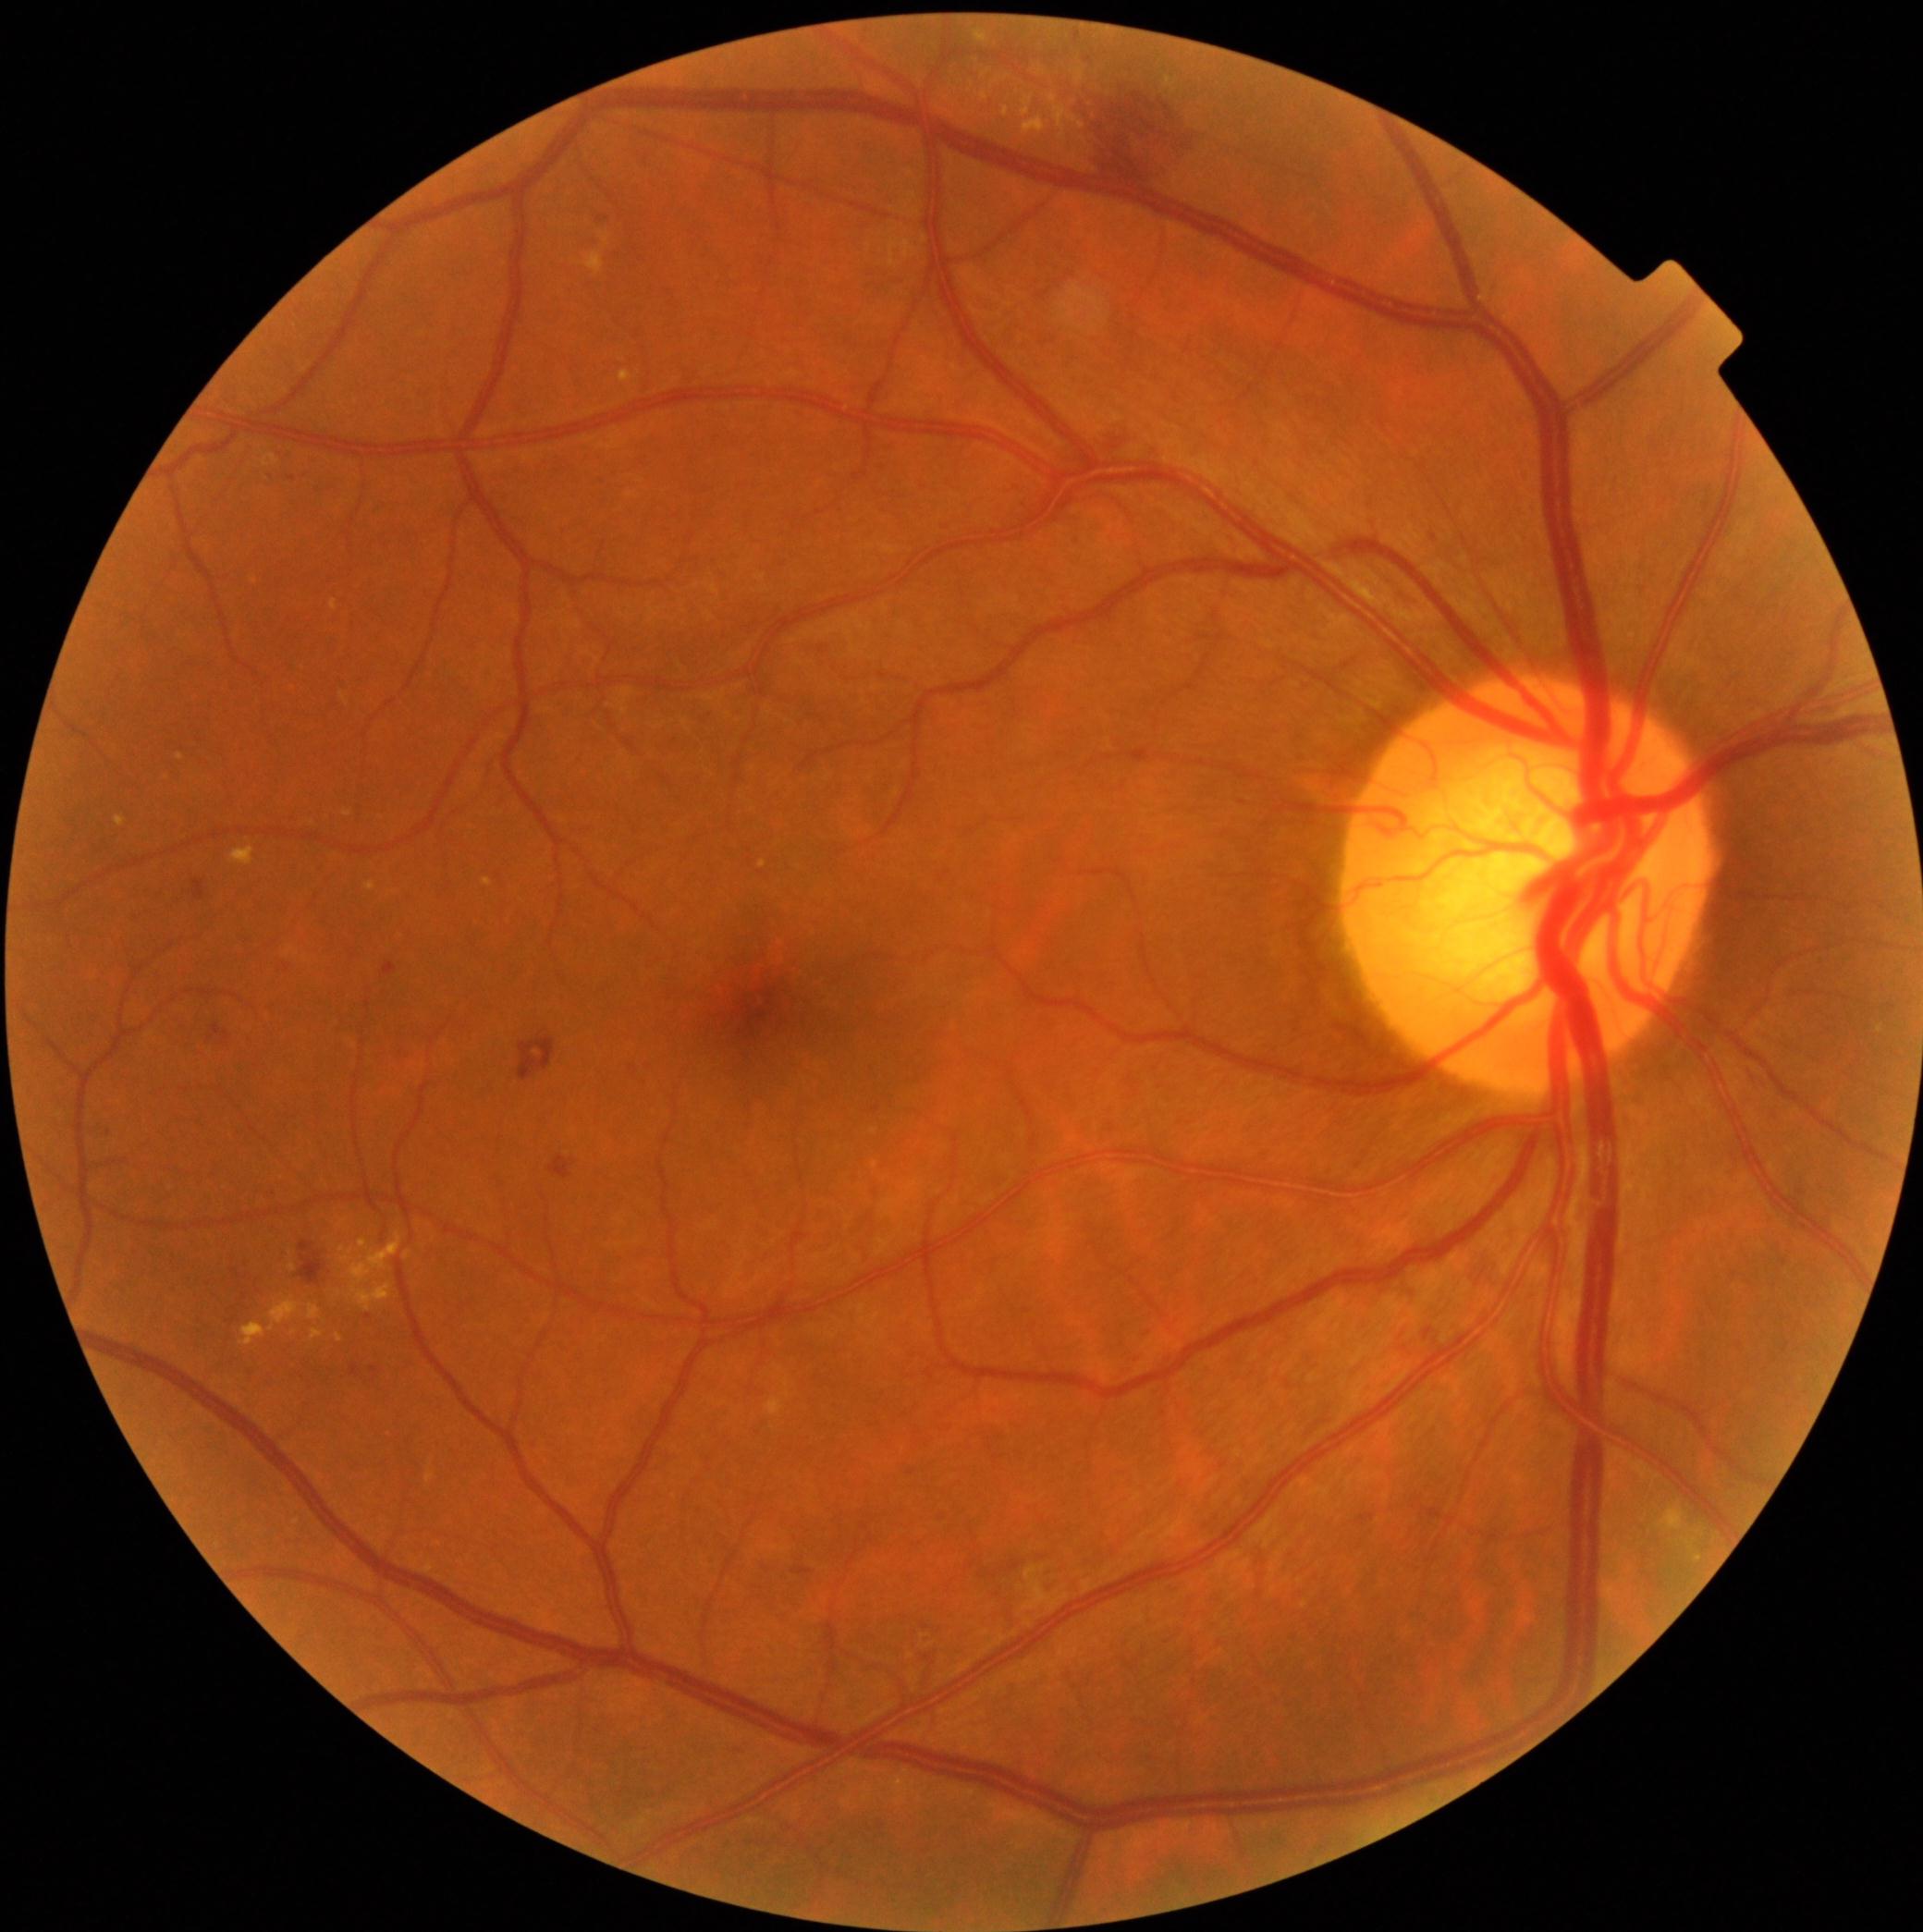
DR grade is 2 — more than just microaneurysms but less than severe NPDR; non-proliferative diabetic retinopathy
Representative lesions:
EXs (partial) = box=[483, 880, 494, 887] | box=[574, 251, 605, 276] | box=[308, 1305, 322, 1320] | box=[231, 848, 256, 867] | box=[1023, 94, 1035, 117] | box=[340, 694, 349, 705] | box=[1024, 1566, 1070, 1610] | box=[1075, 68, 1084, 85] | box=[760, 861, 767, 869] | box=[426, 1472, 435, 1483]
Small EXs near 340/1338 | 343/1250 | 986/75 | 1082/139